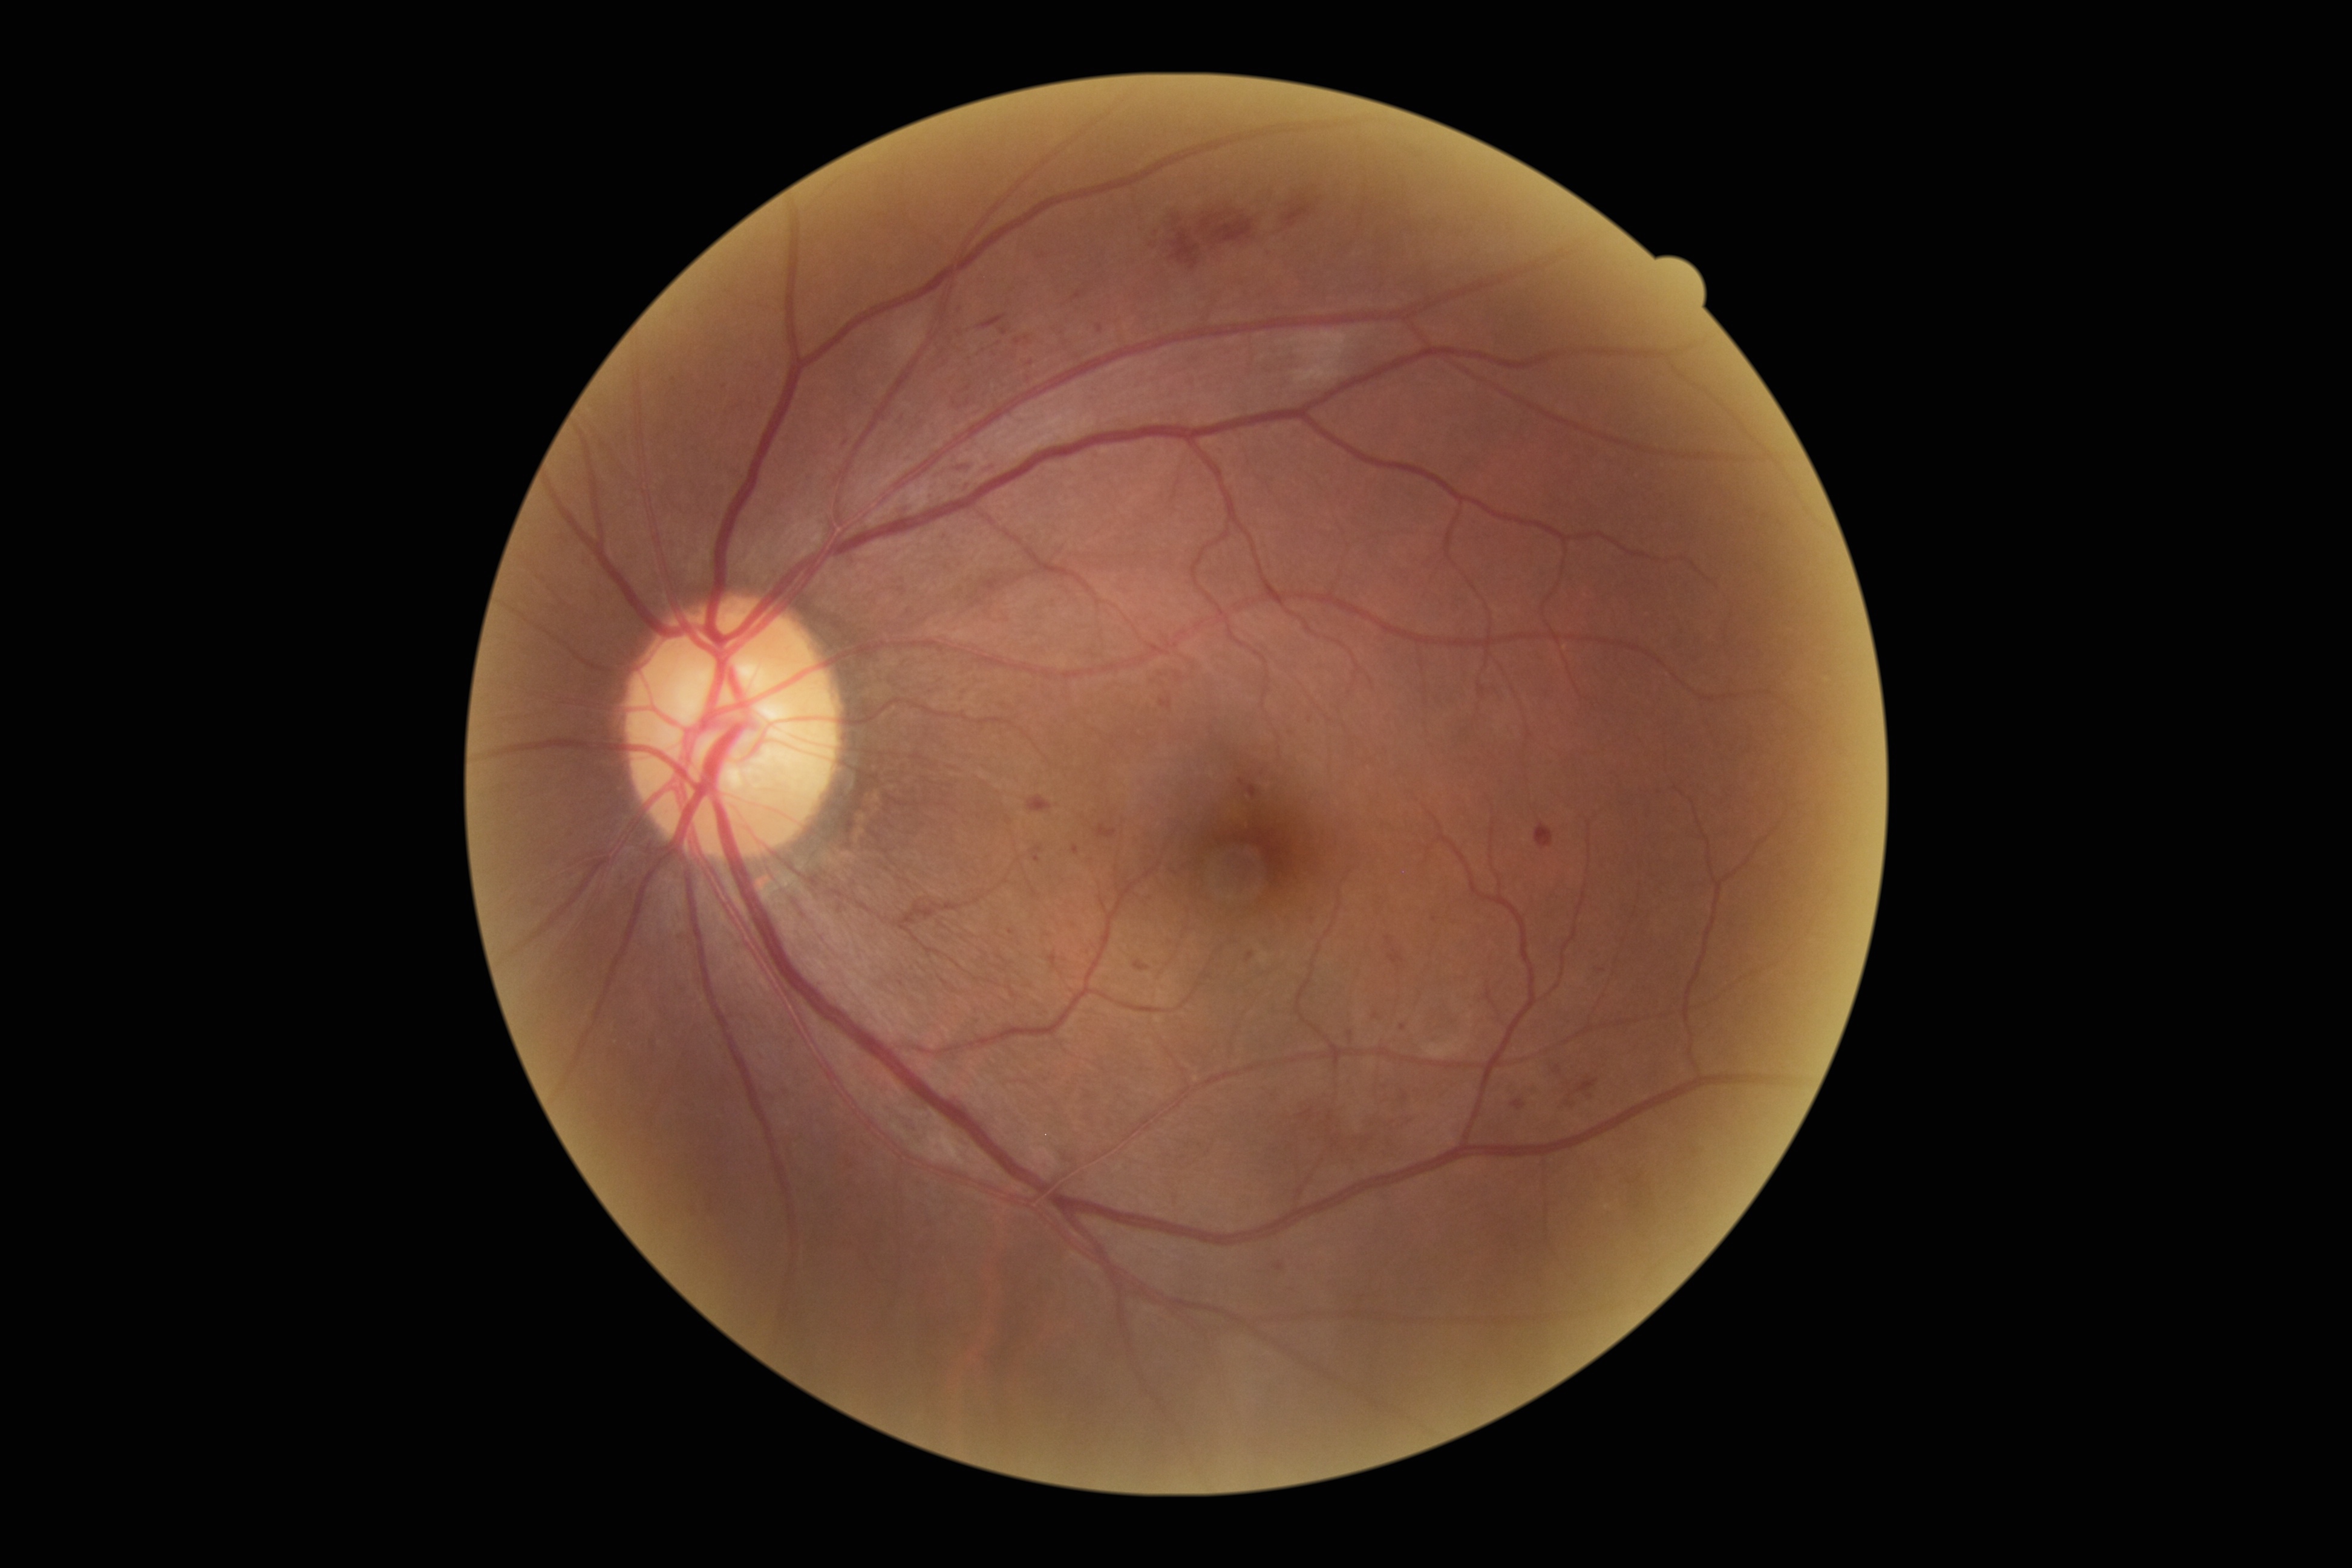
Diabetic retinopathy (DR): grade 2.
DR class: non-proliferative diabetic retinopathy.